CFP · 2352x1568px · 45° field of view
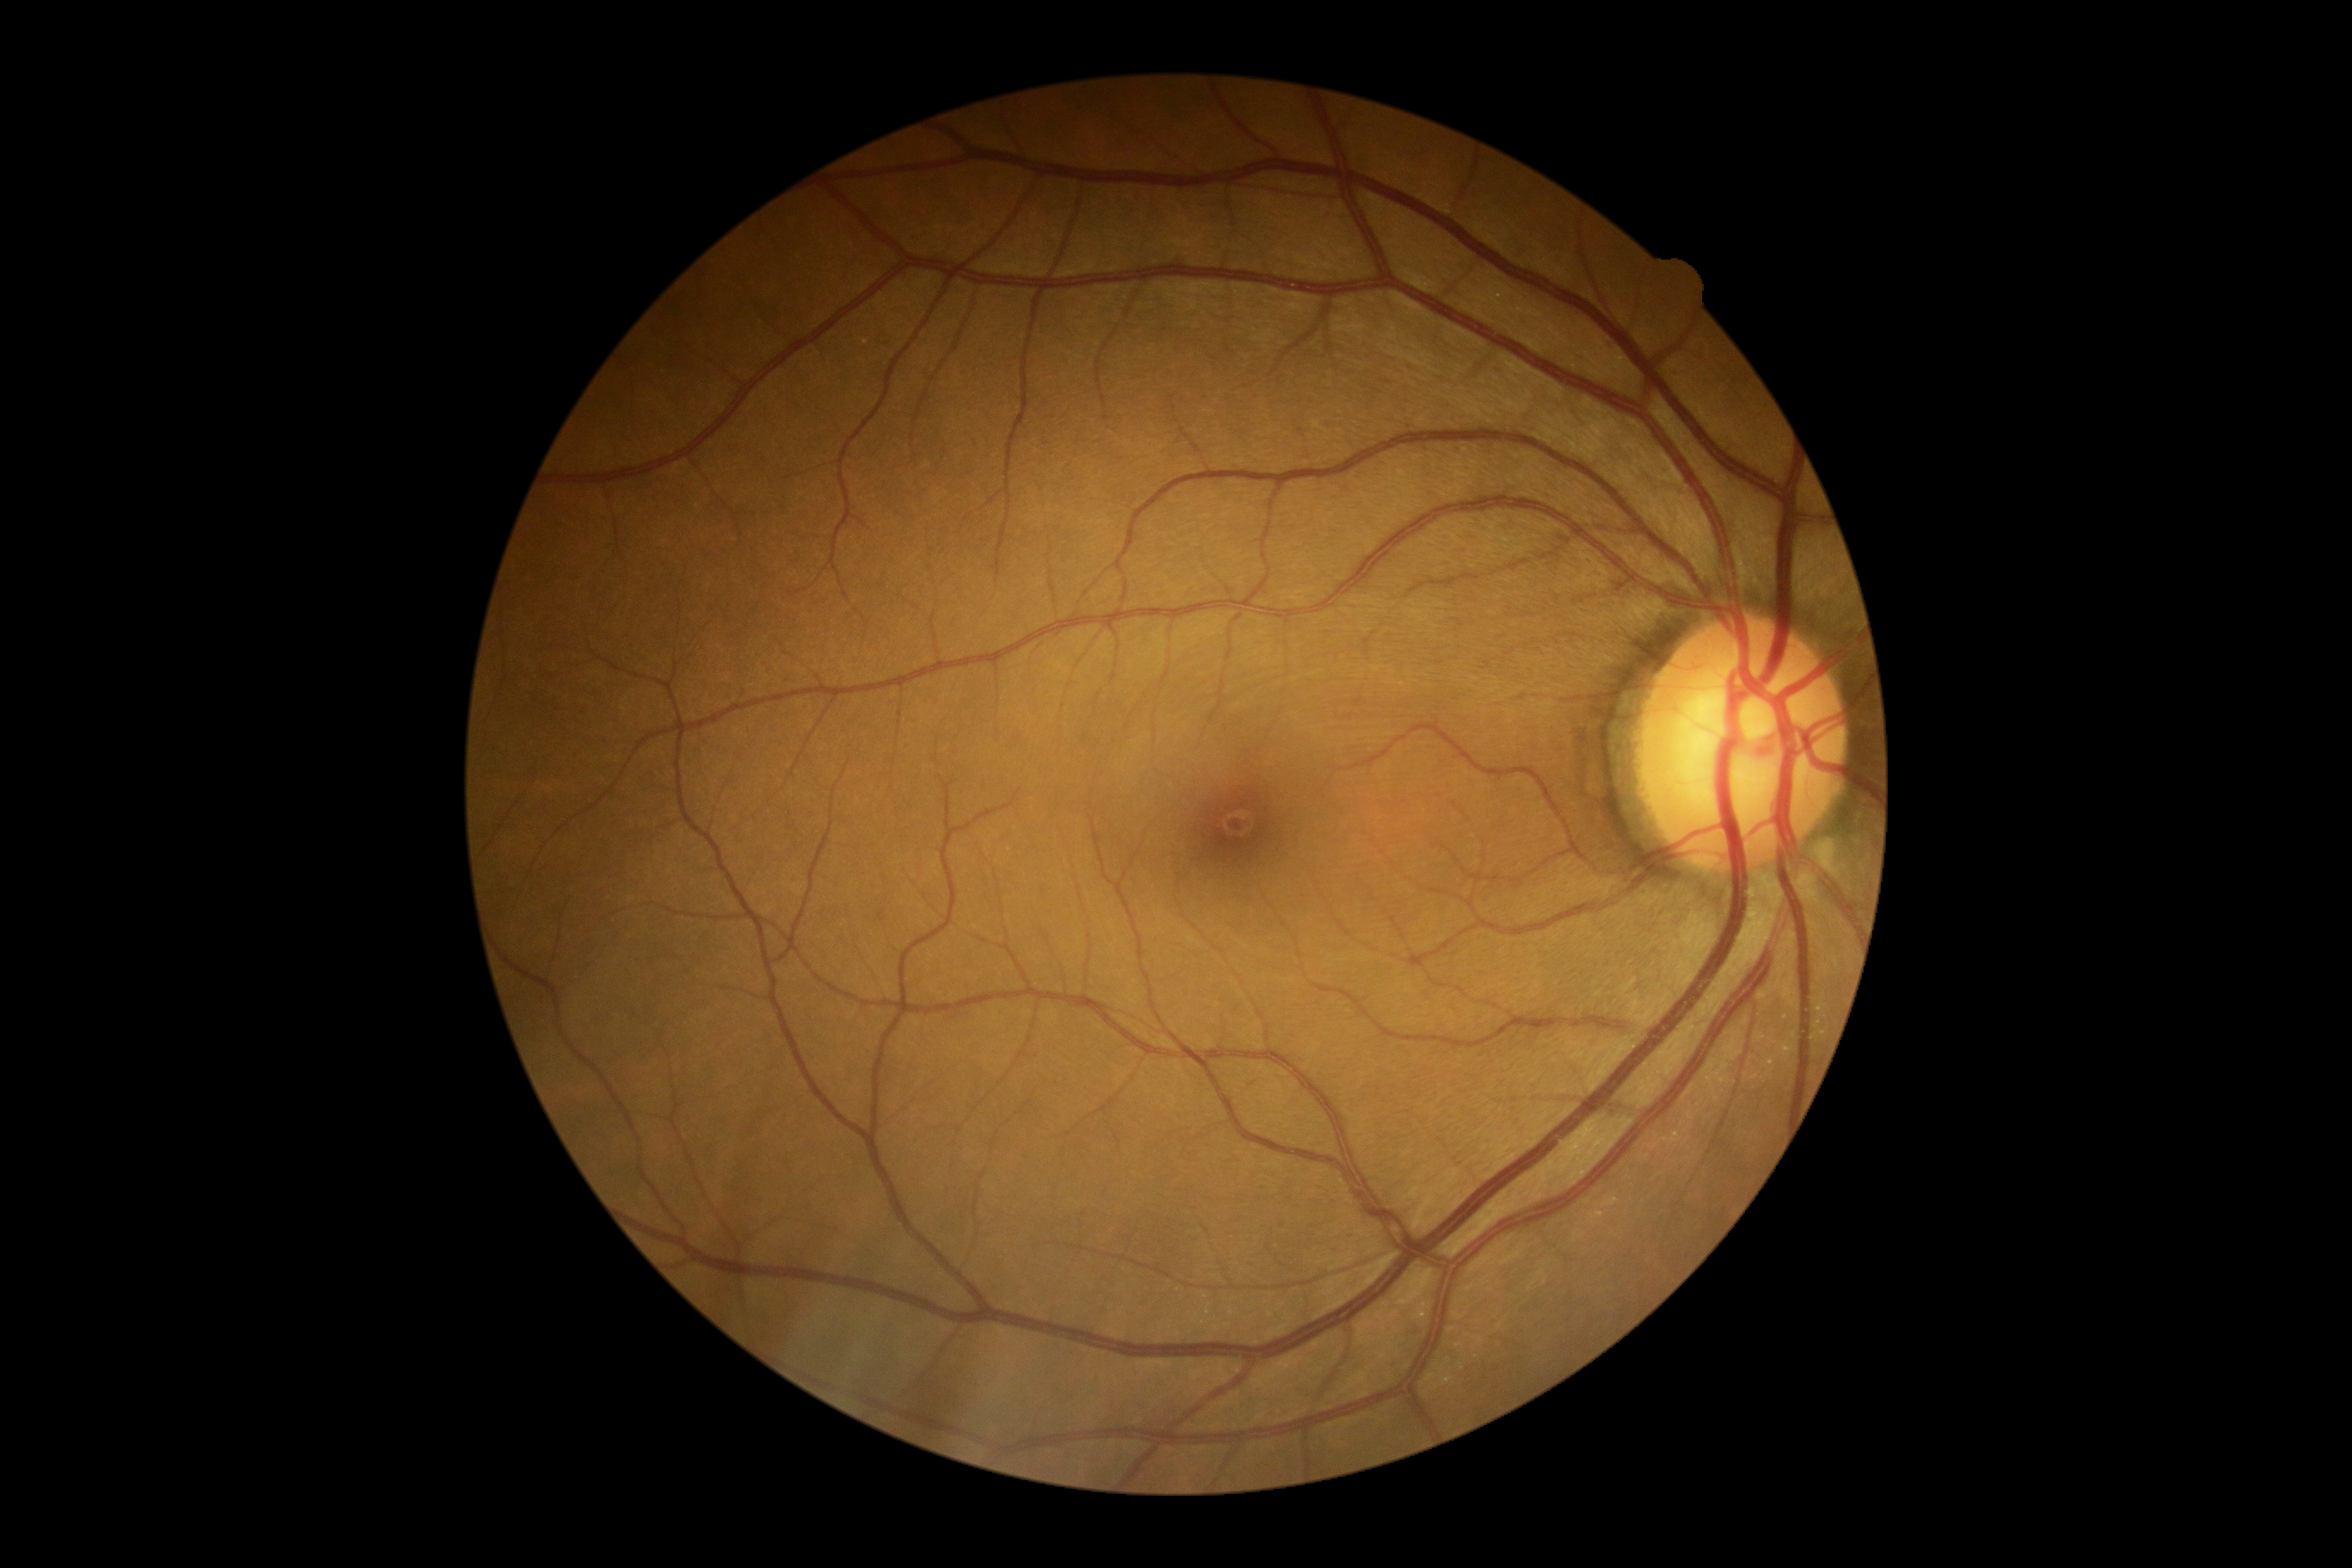   dr_grade: 0
  dr_impression: no apparent DR